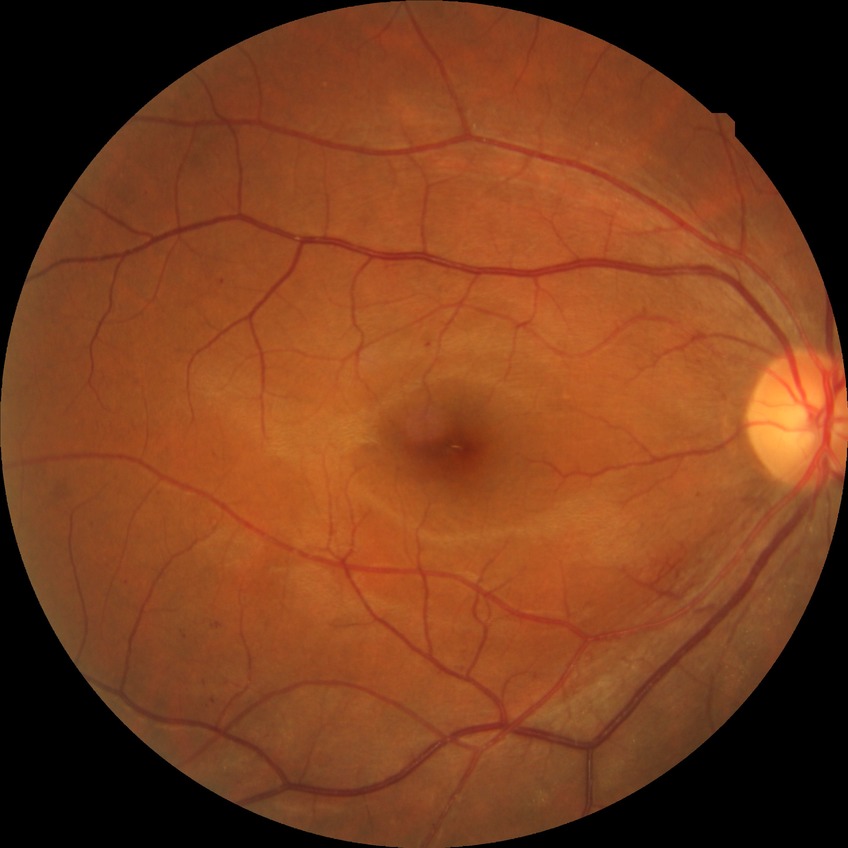 Davis grade@SDR.